45-degree field of view, retinal fundus photograph:
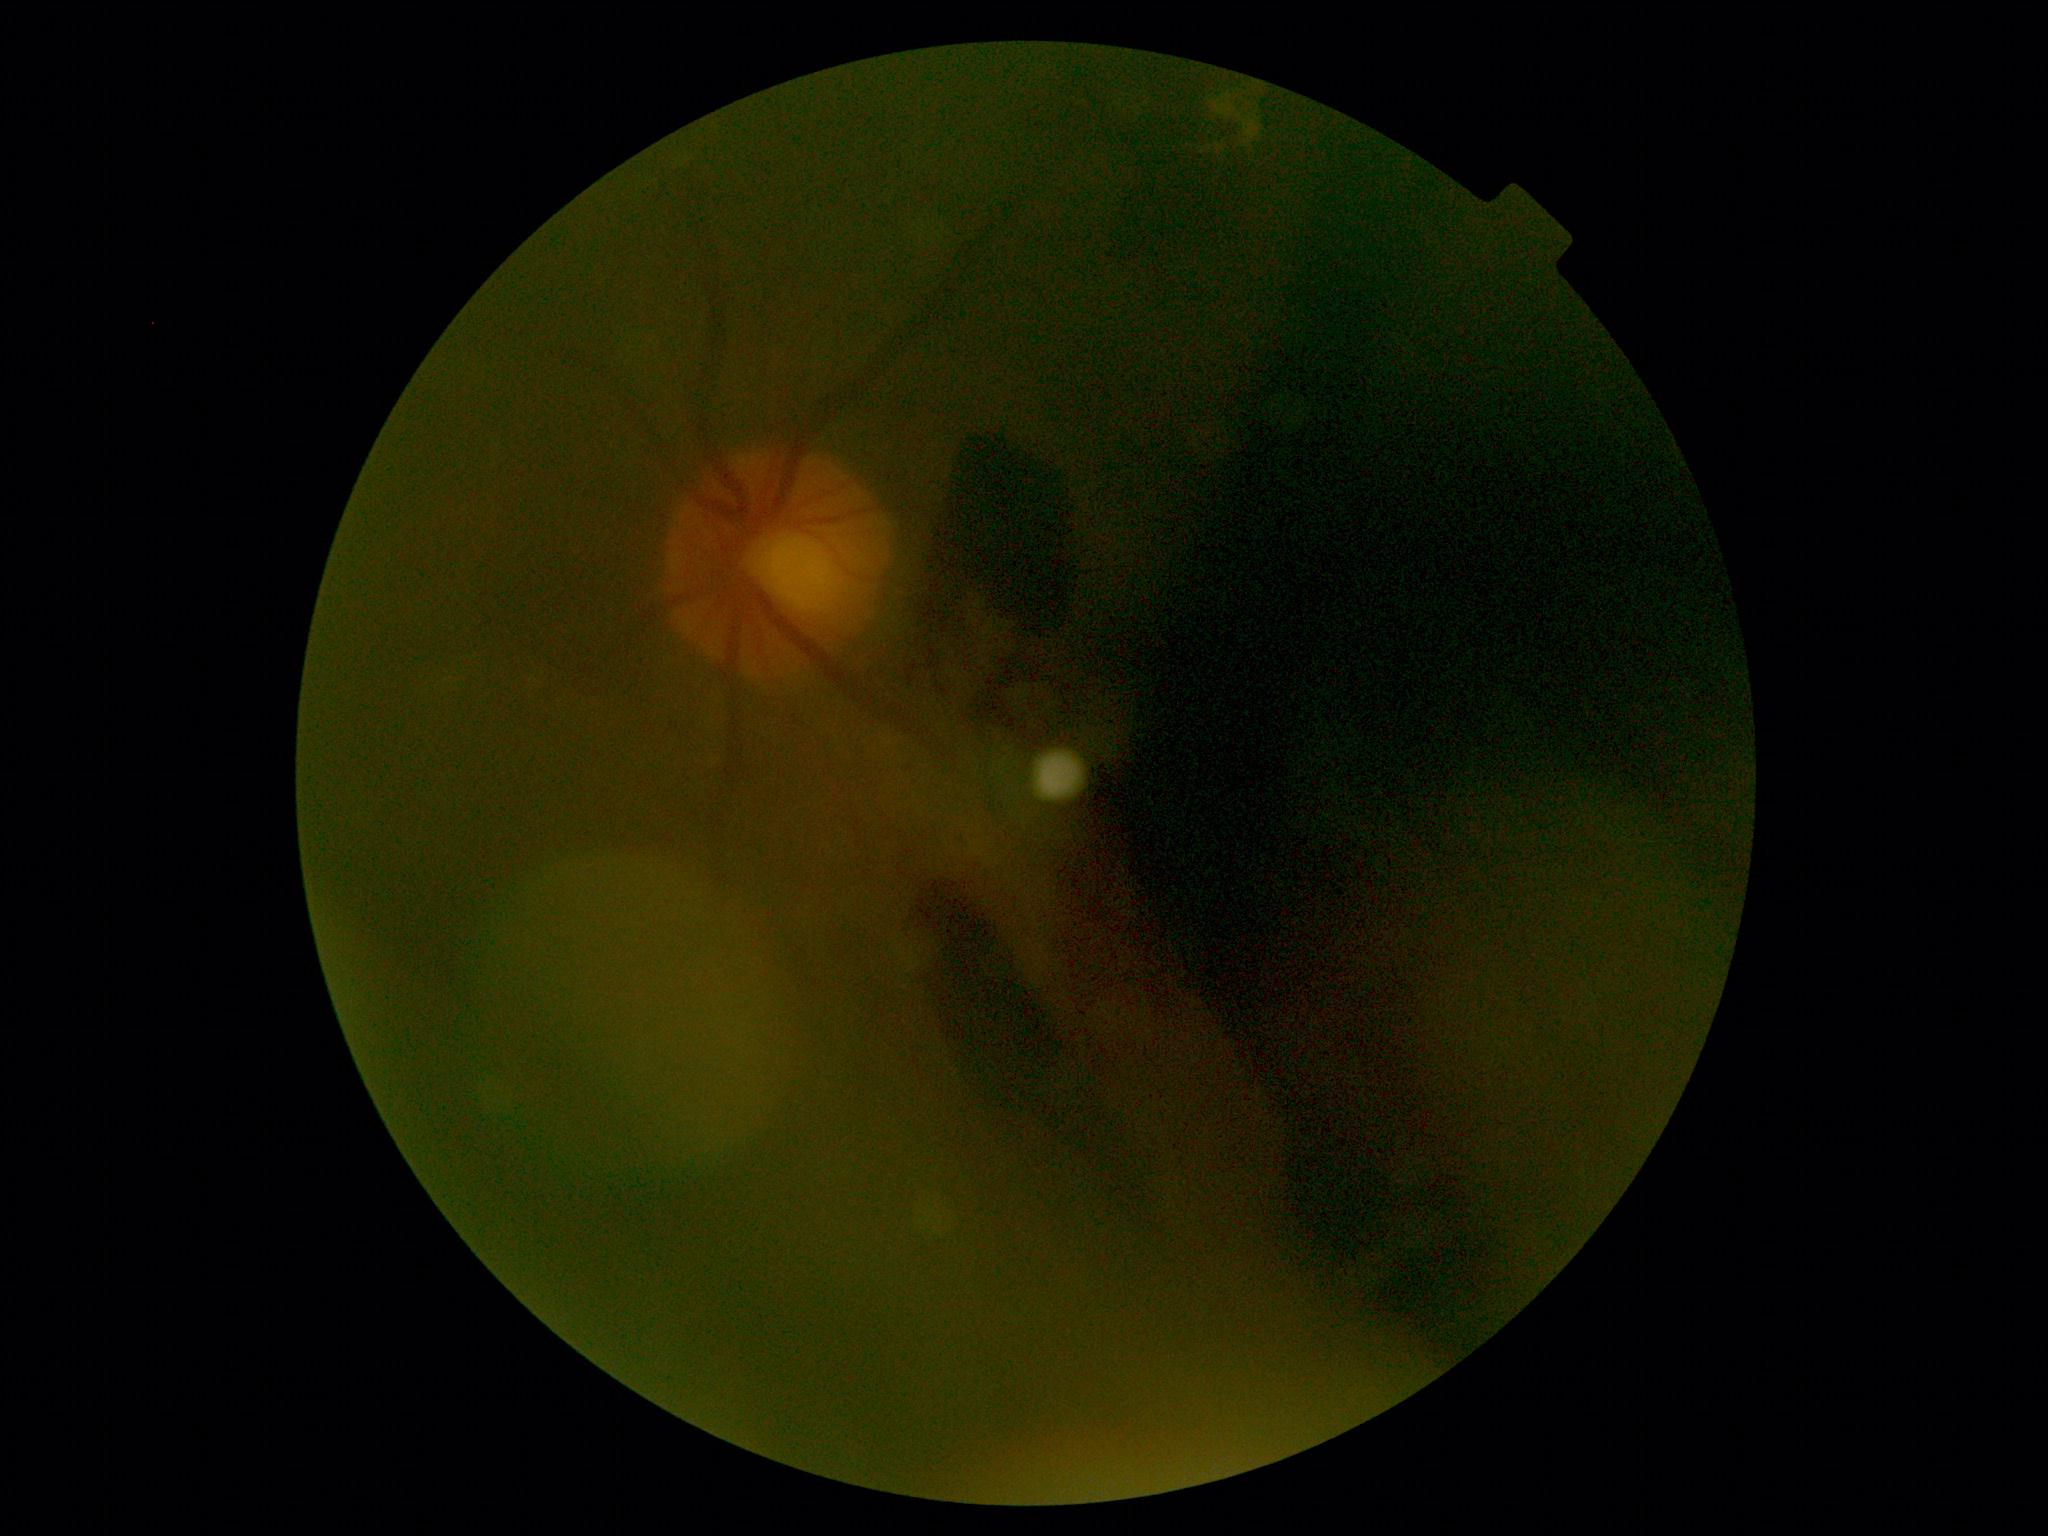

DR class: proliferative diabetic retinopathy. DR grade is proliferative diabetic retinopathy (4).